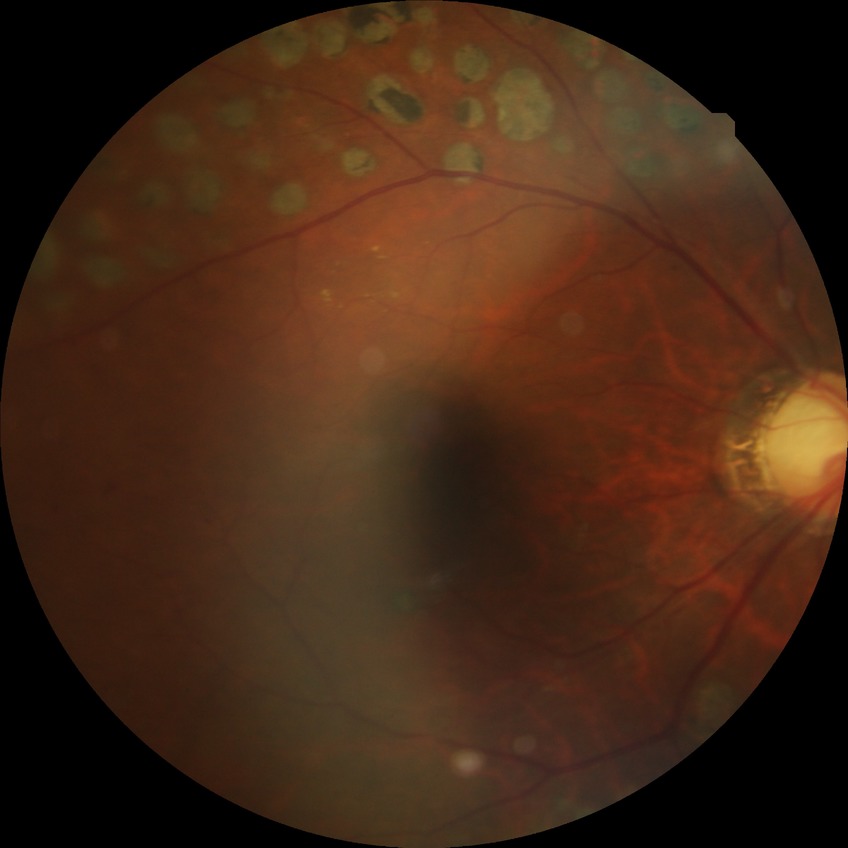
{"davis_grade": "PDR (proliferative diabetic retinopathy)"}